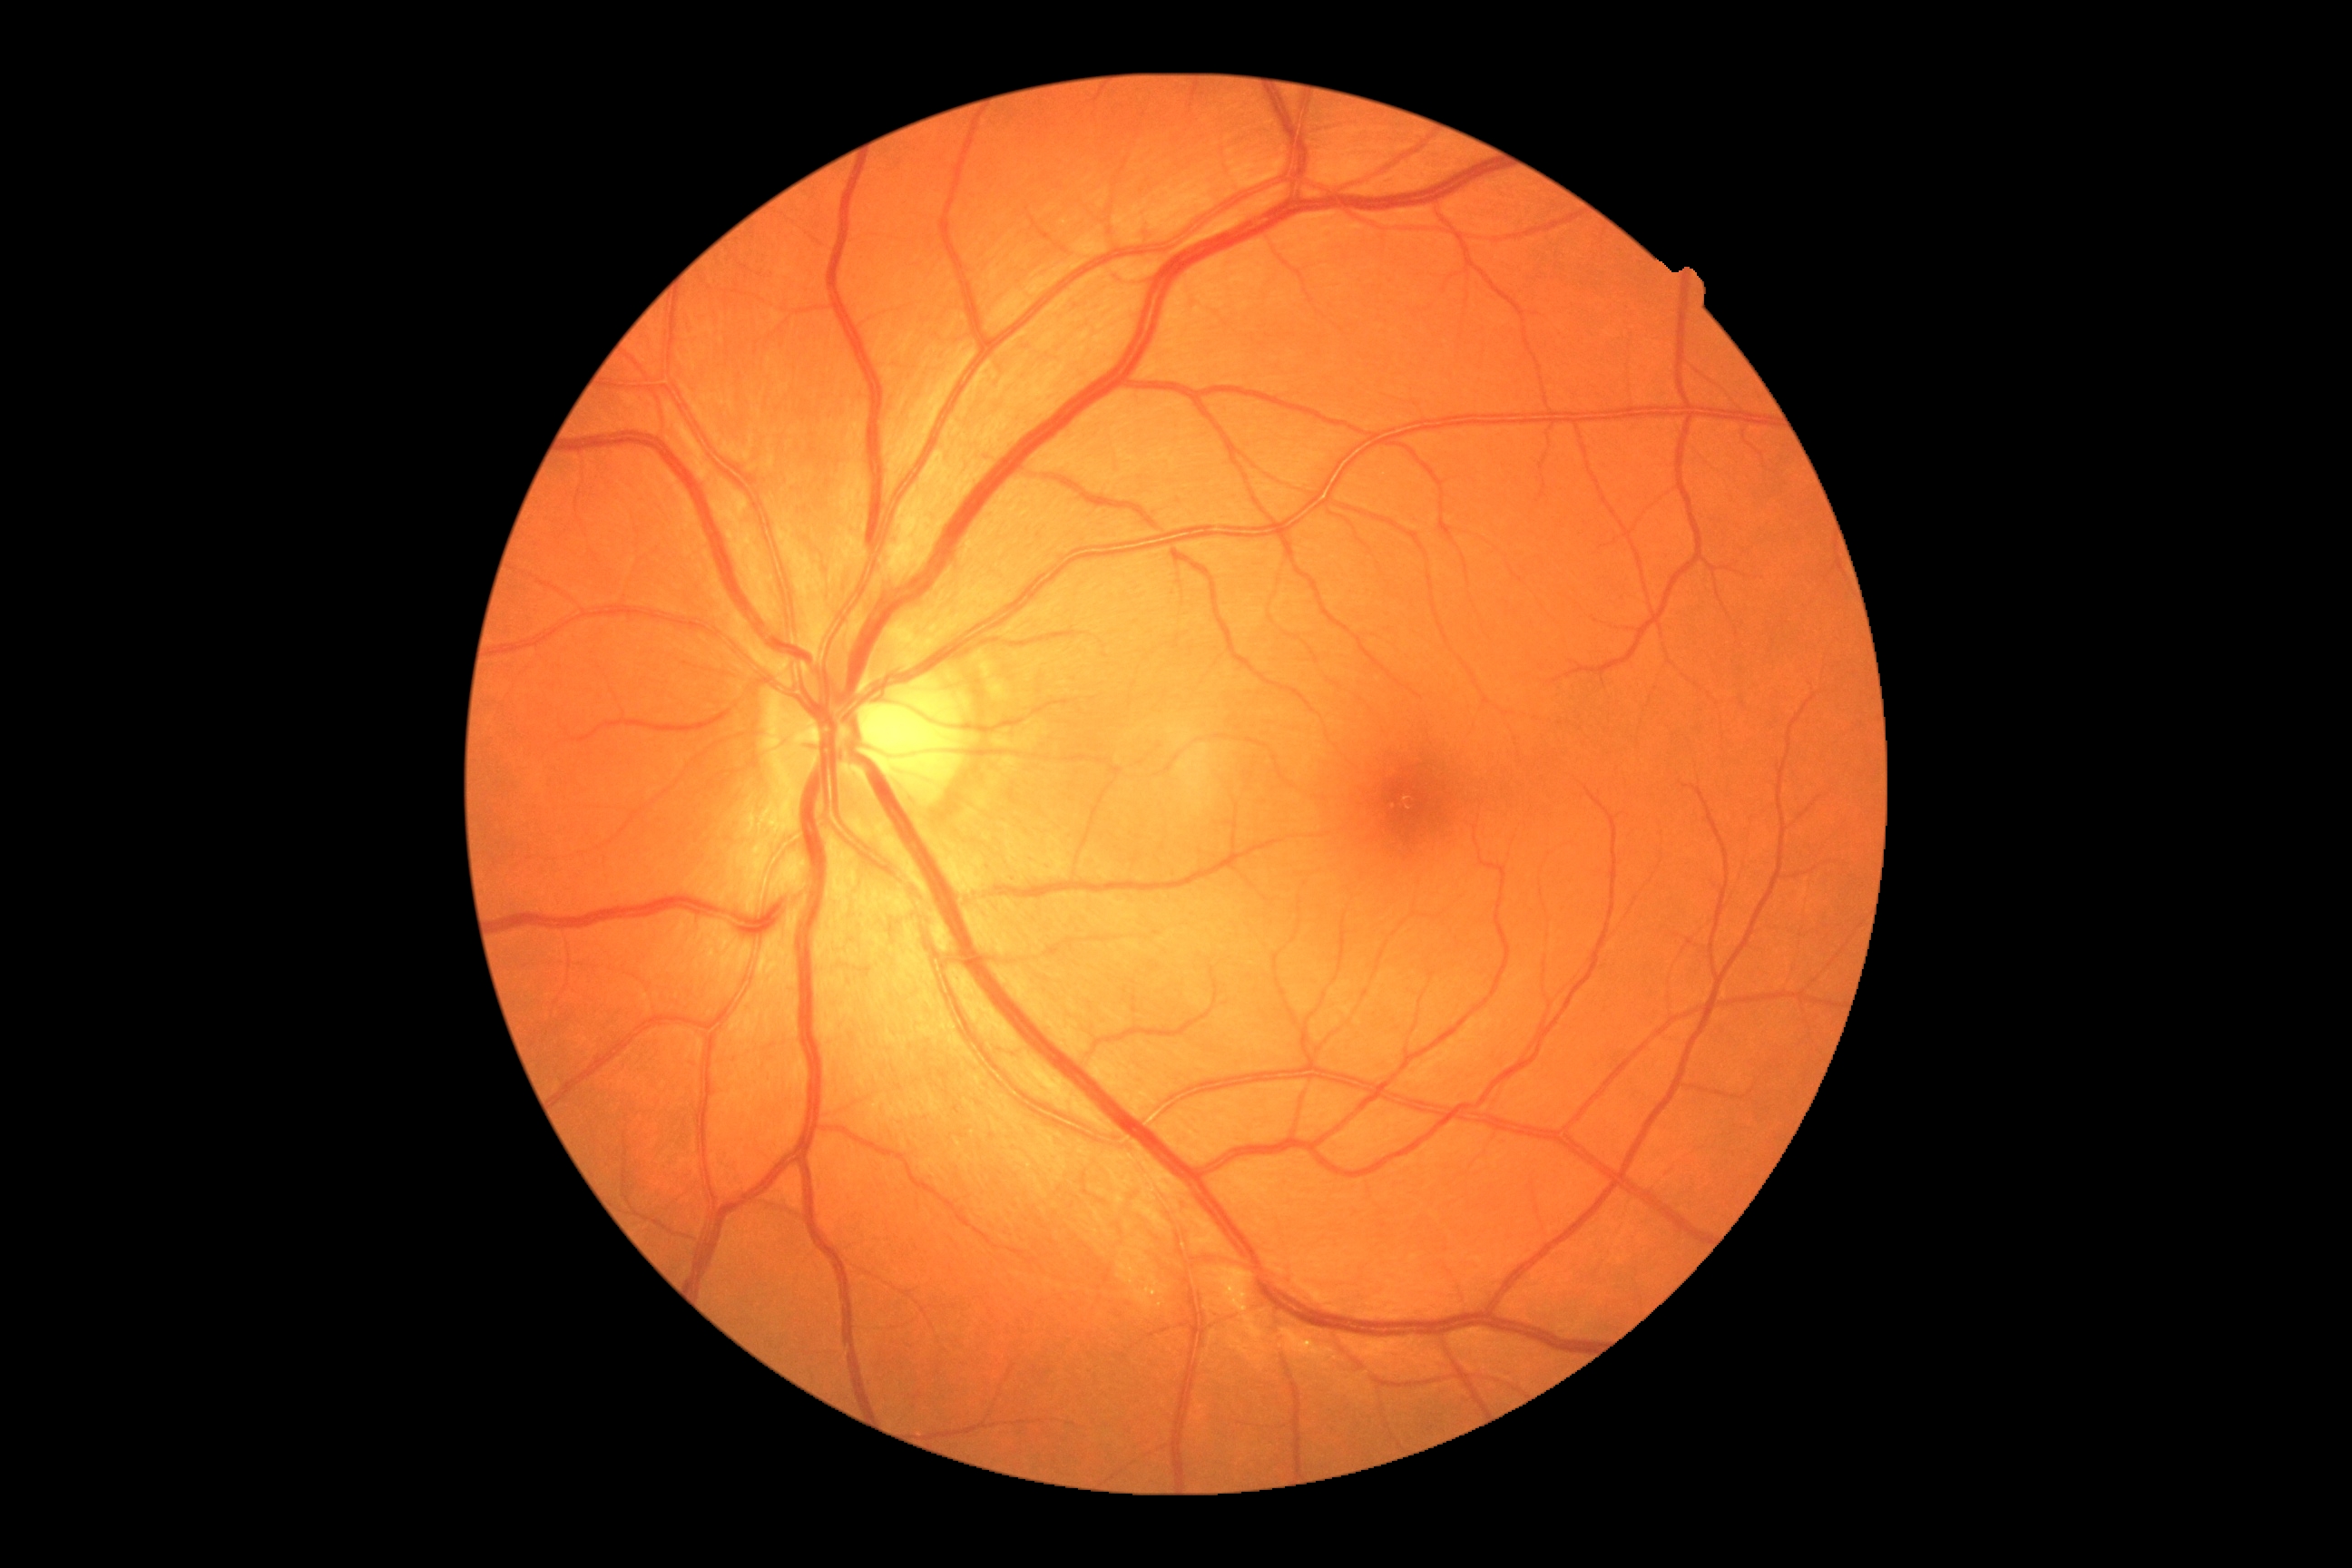

No signs of diabetic retinopathy.
DR severity: grade 0.